2048 by 1536 pixels. Color fundus photograph.
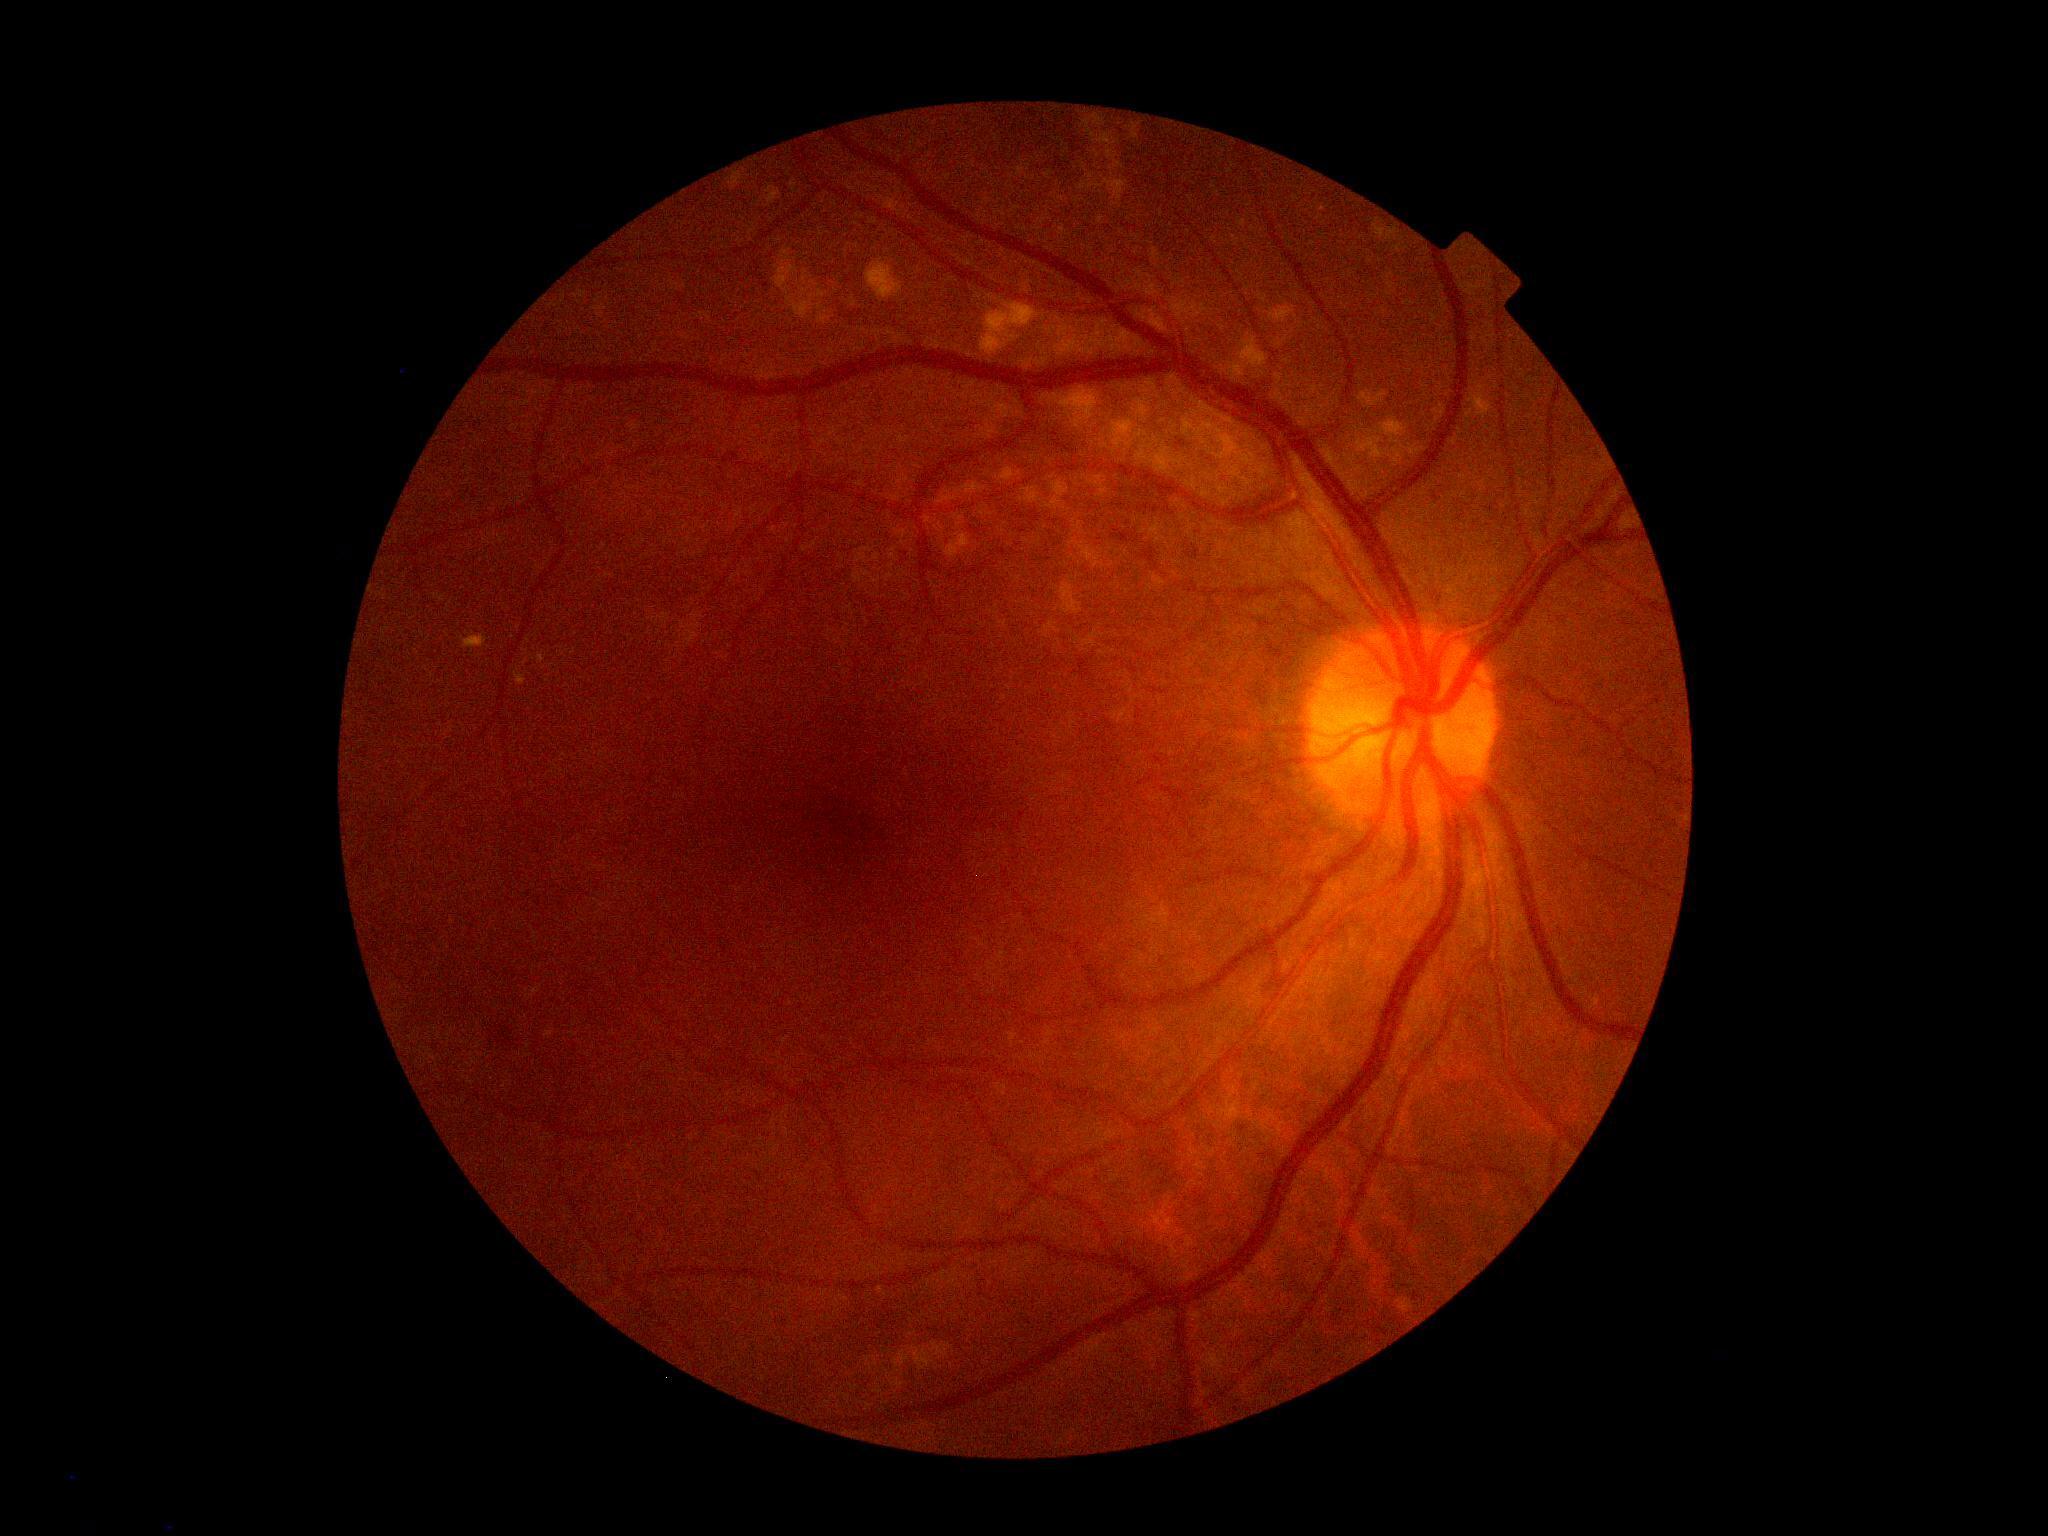
Diabetic retinopathy: grade 2.